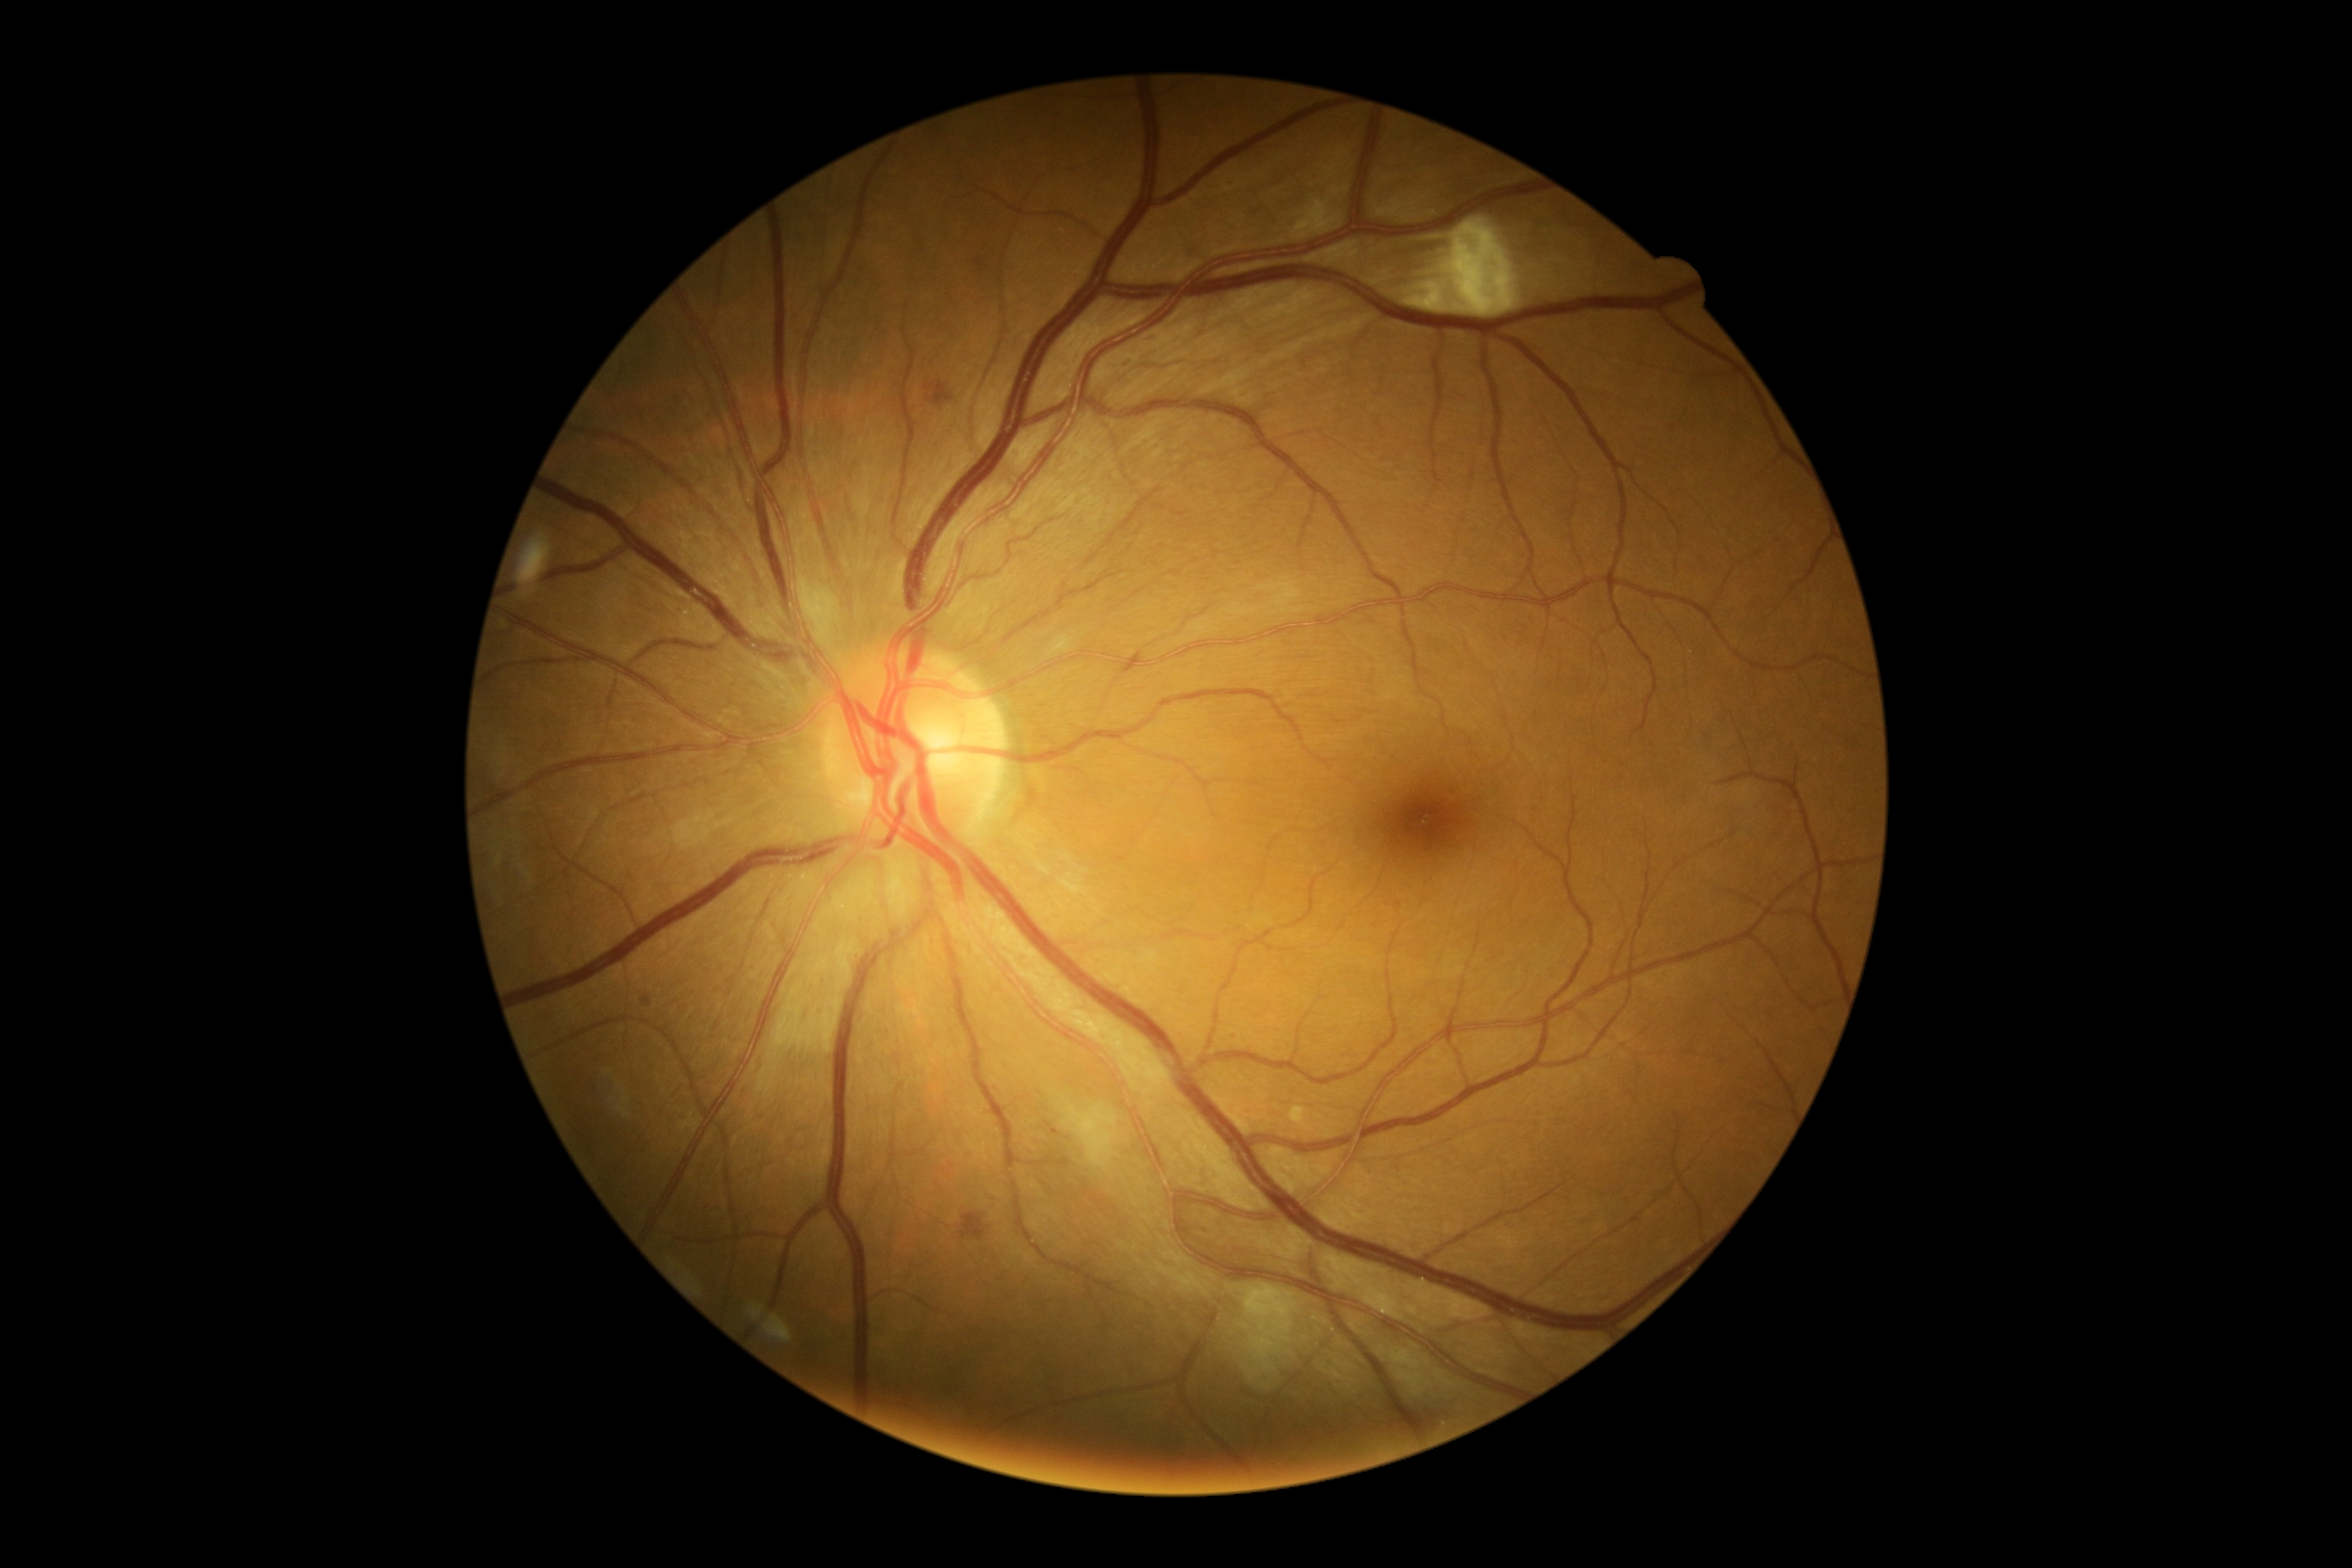 Diabetic retinopathy severity: grade 2 (moderate NPDR).